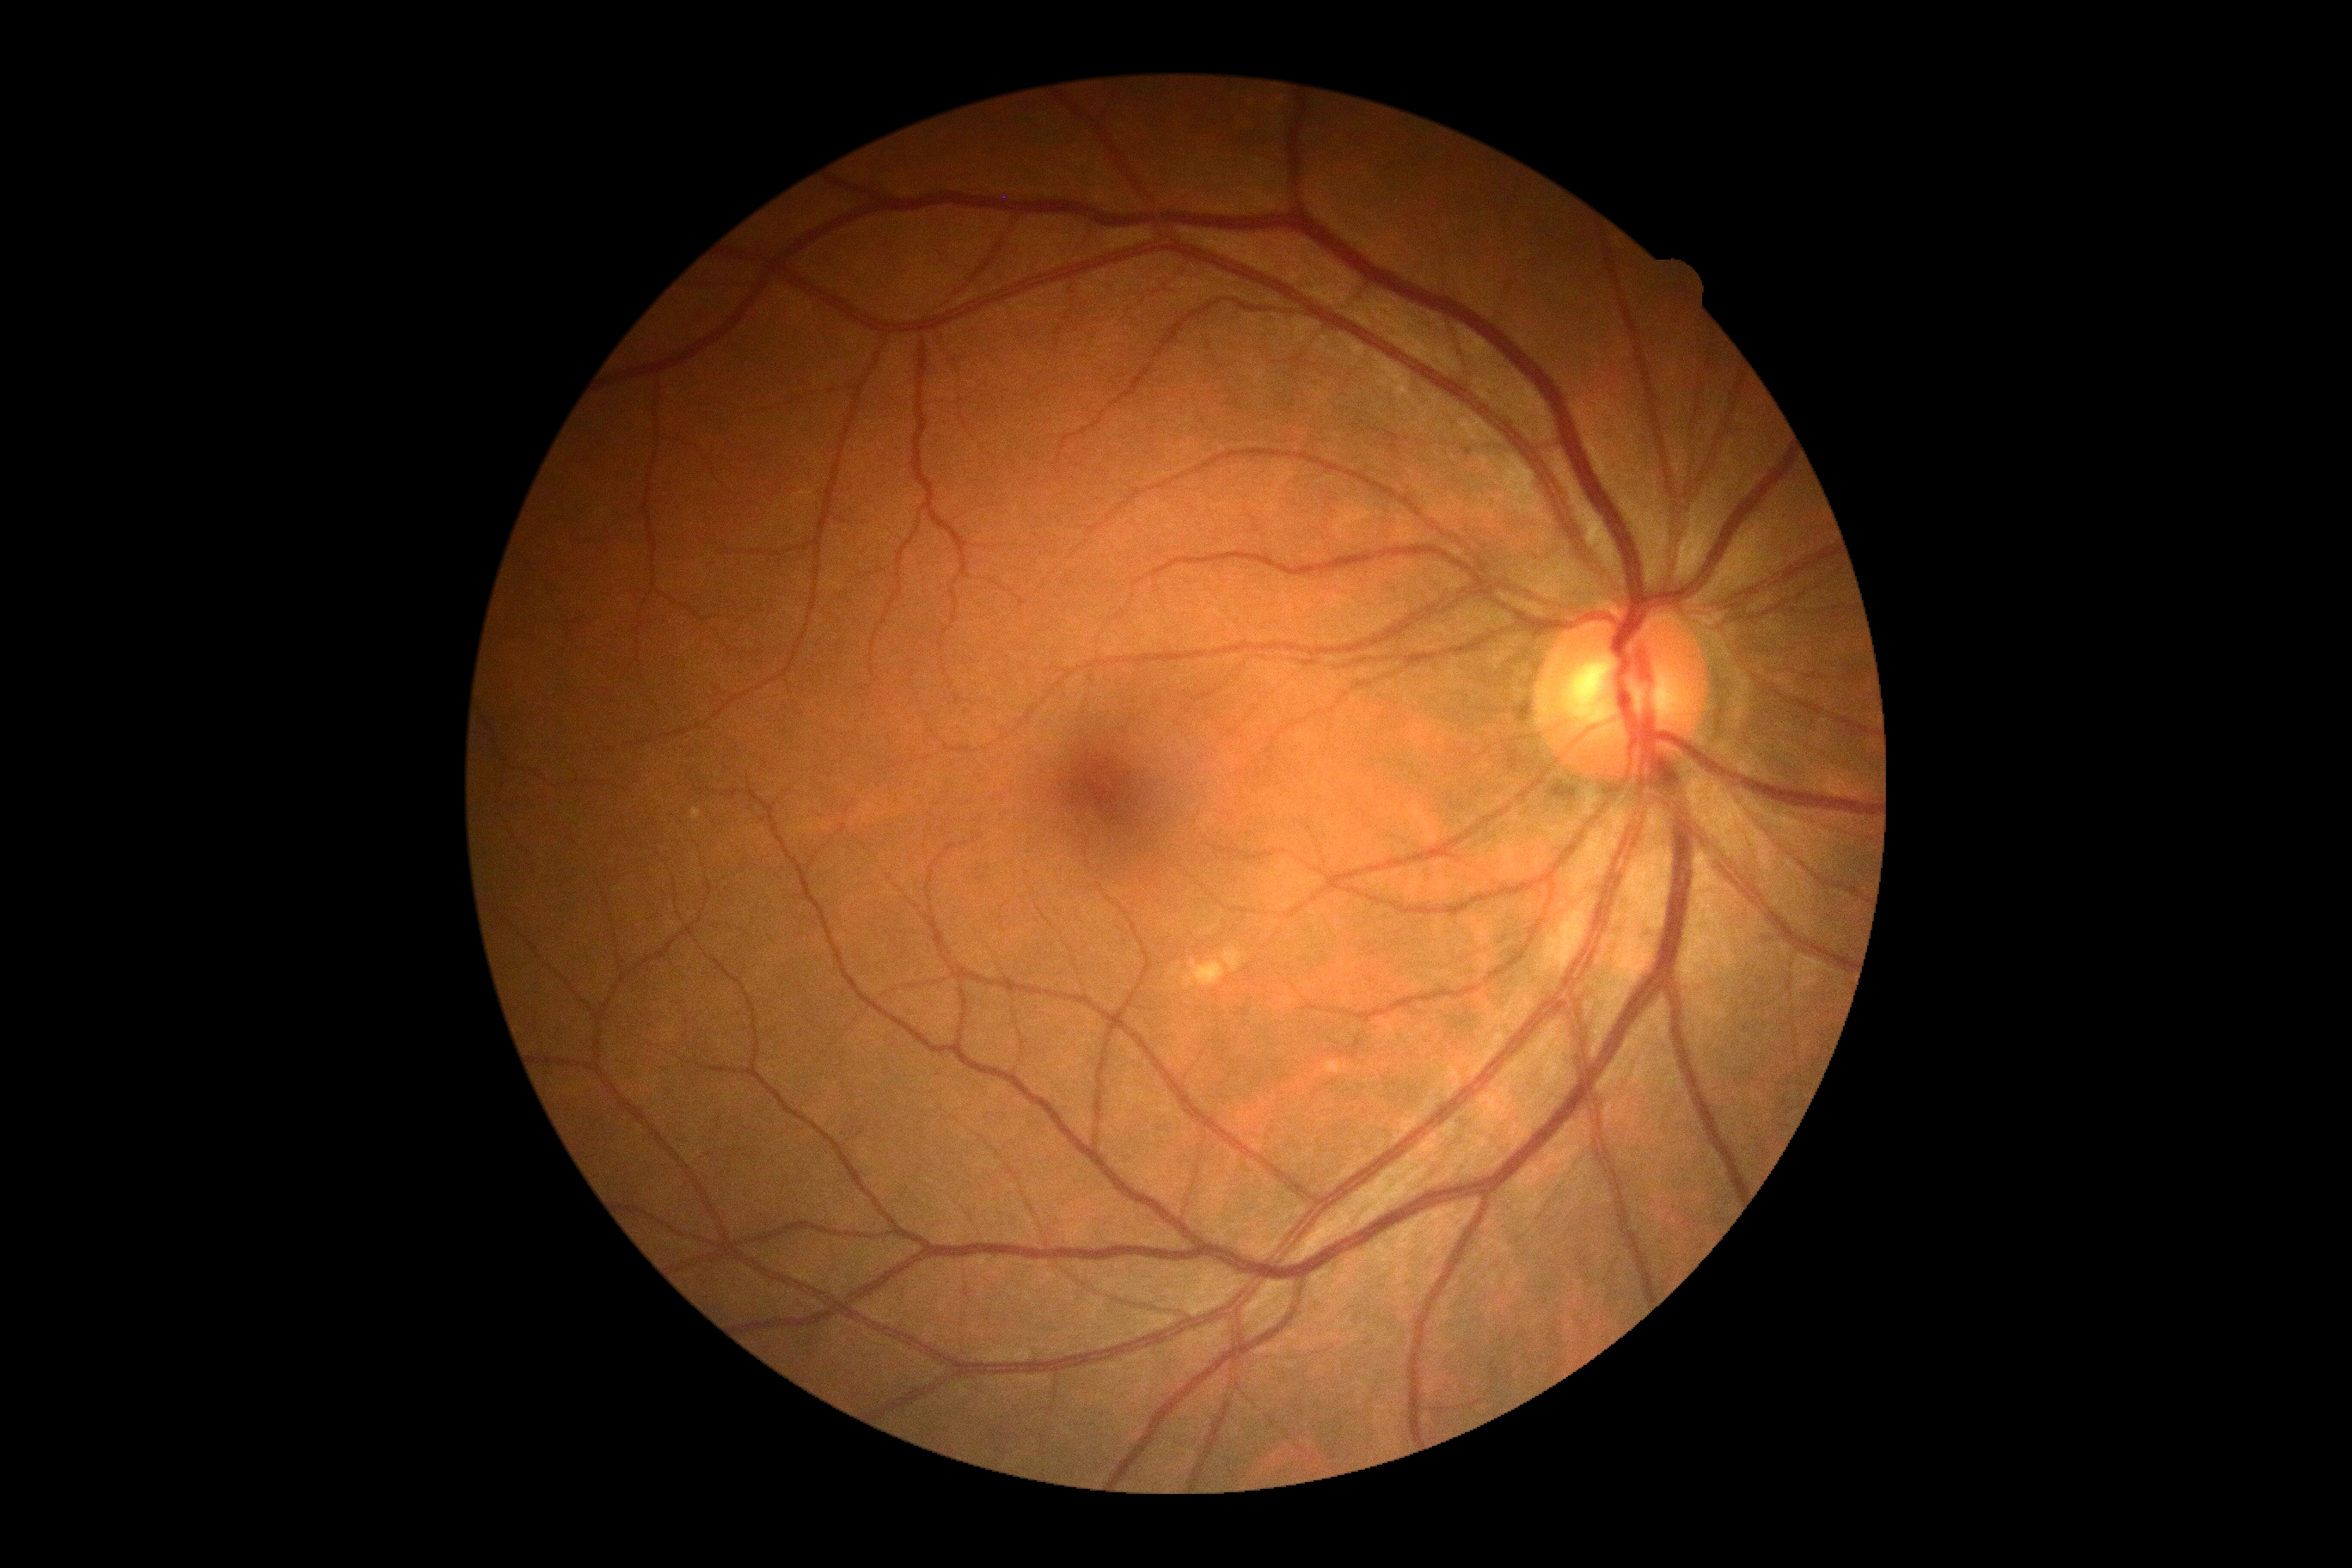
dr_grade: 0/4